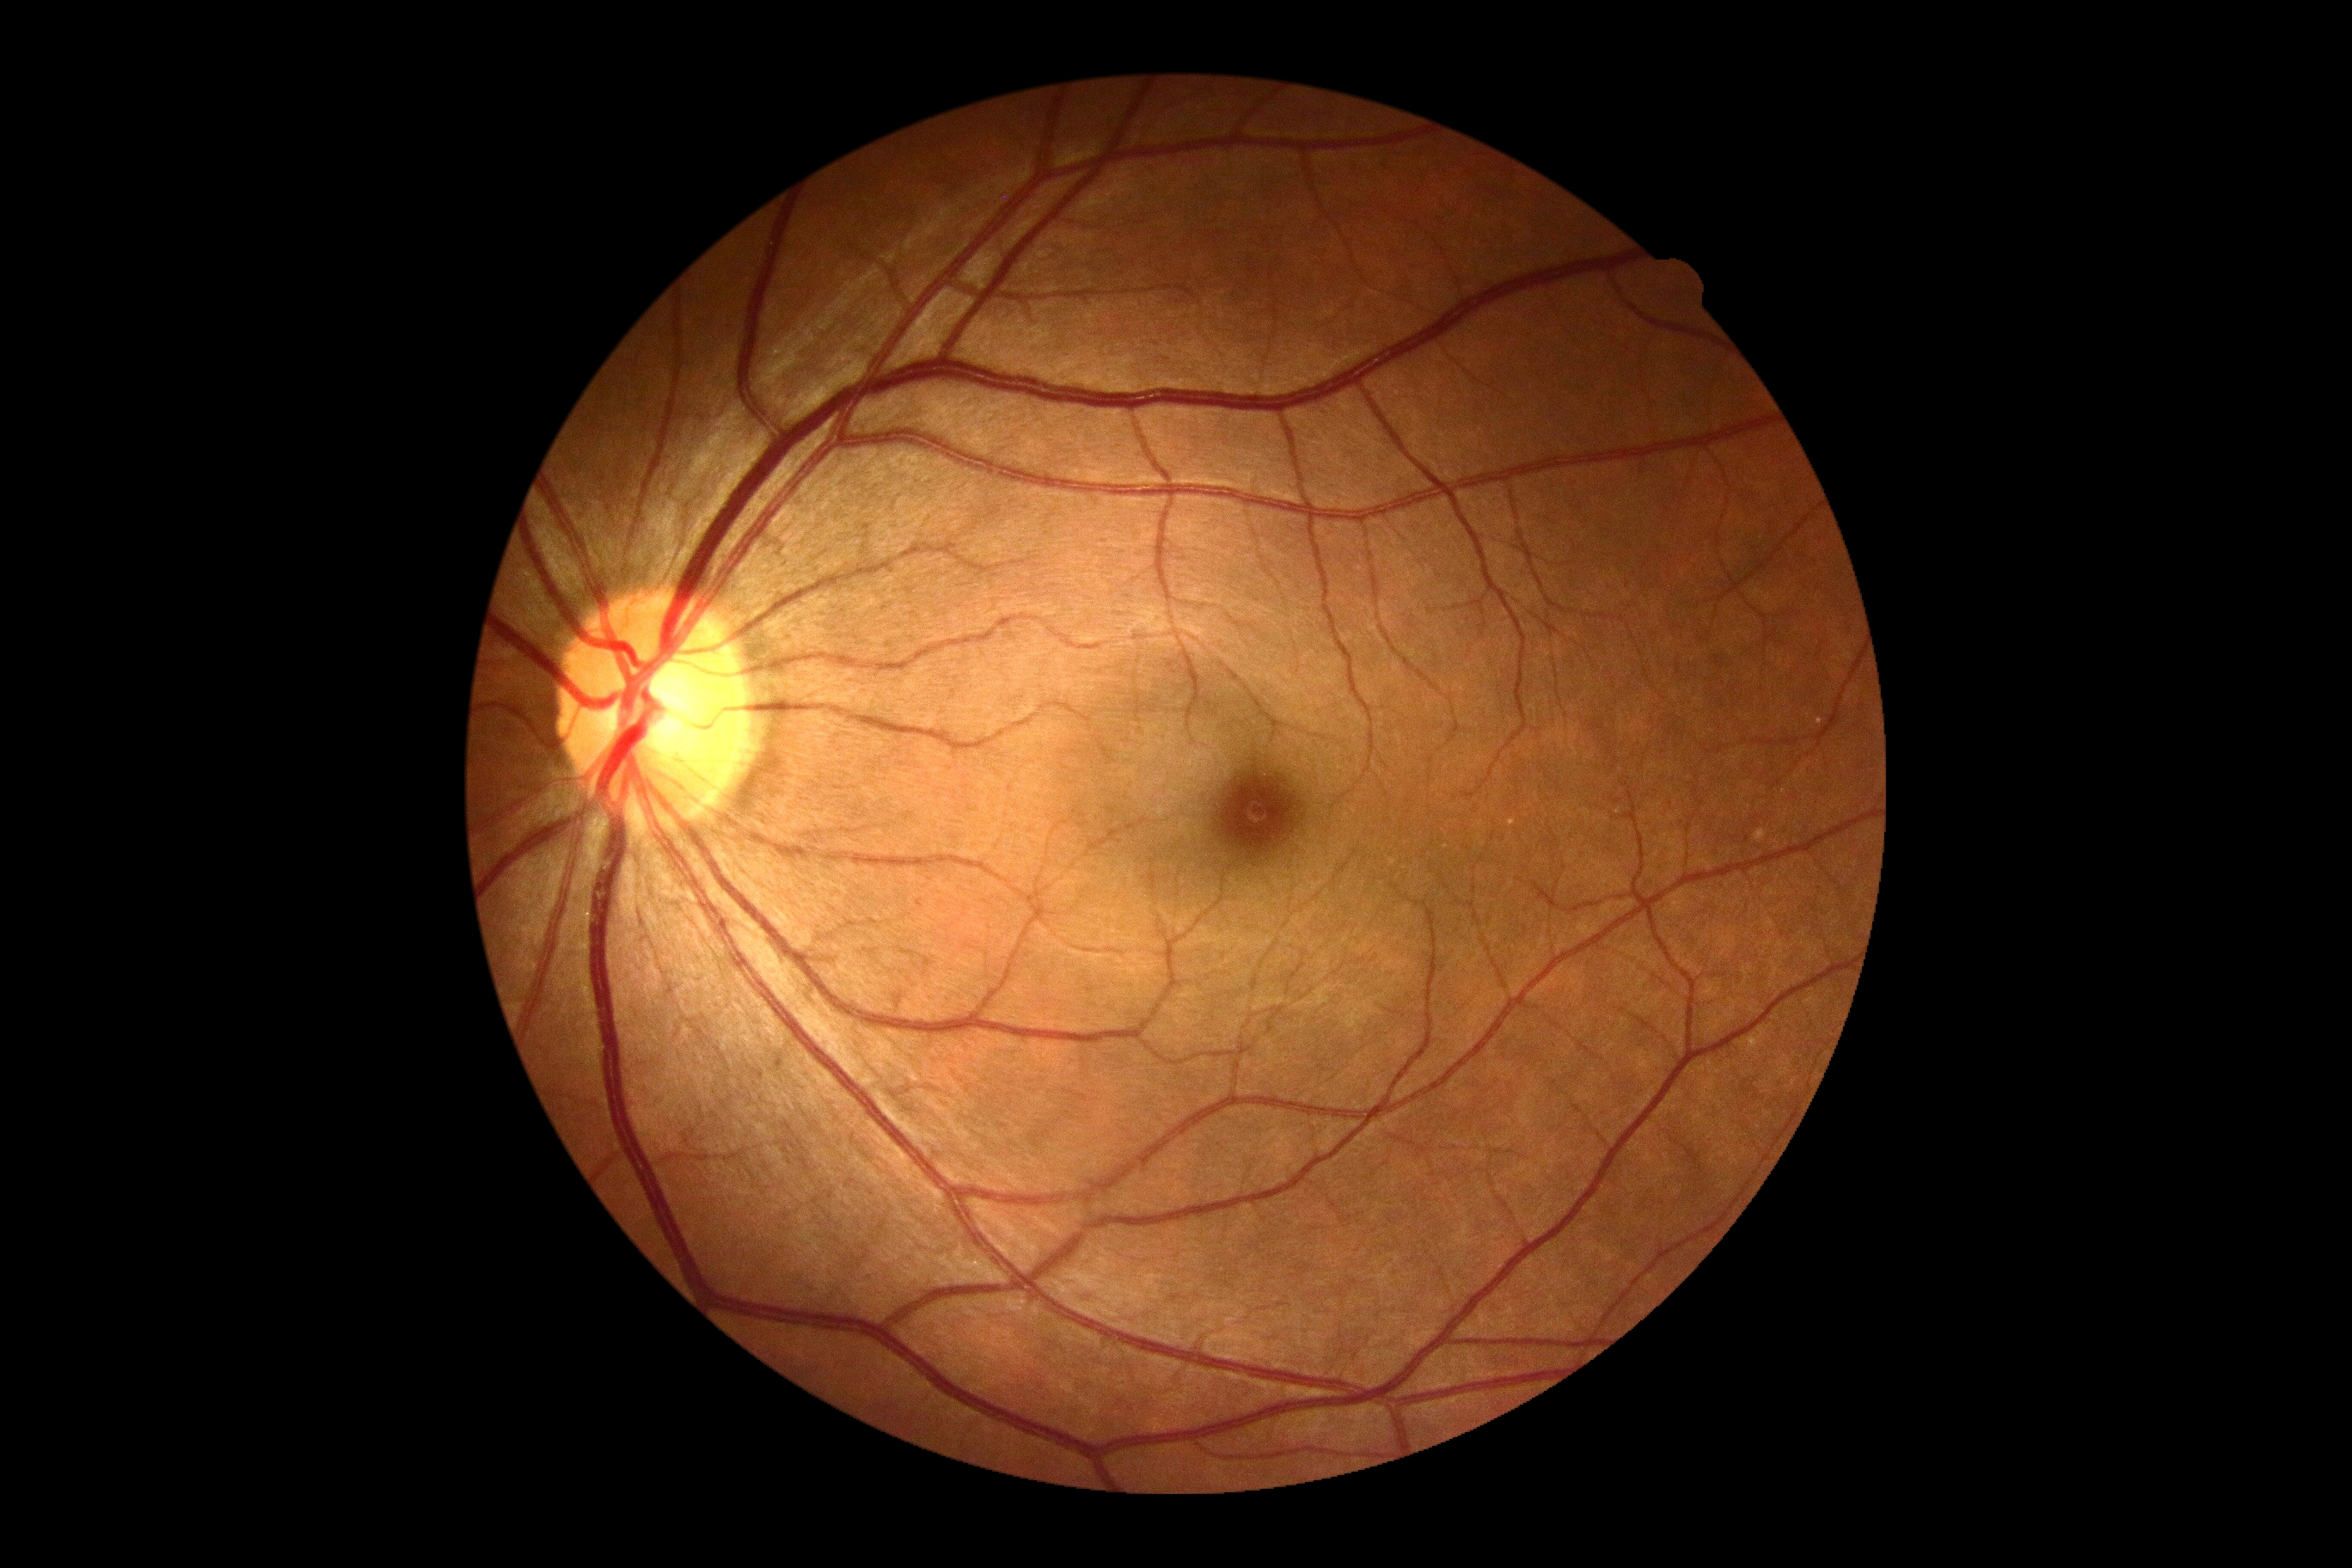 DR impression = negative for DR | retinopathy grade = no apparent diabetic retinopathy (0).